Color fundus photograph · 45° FOV
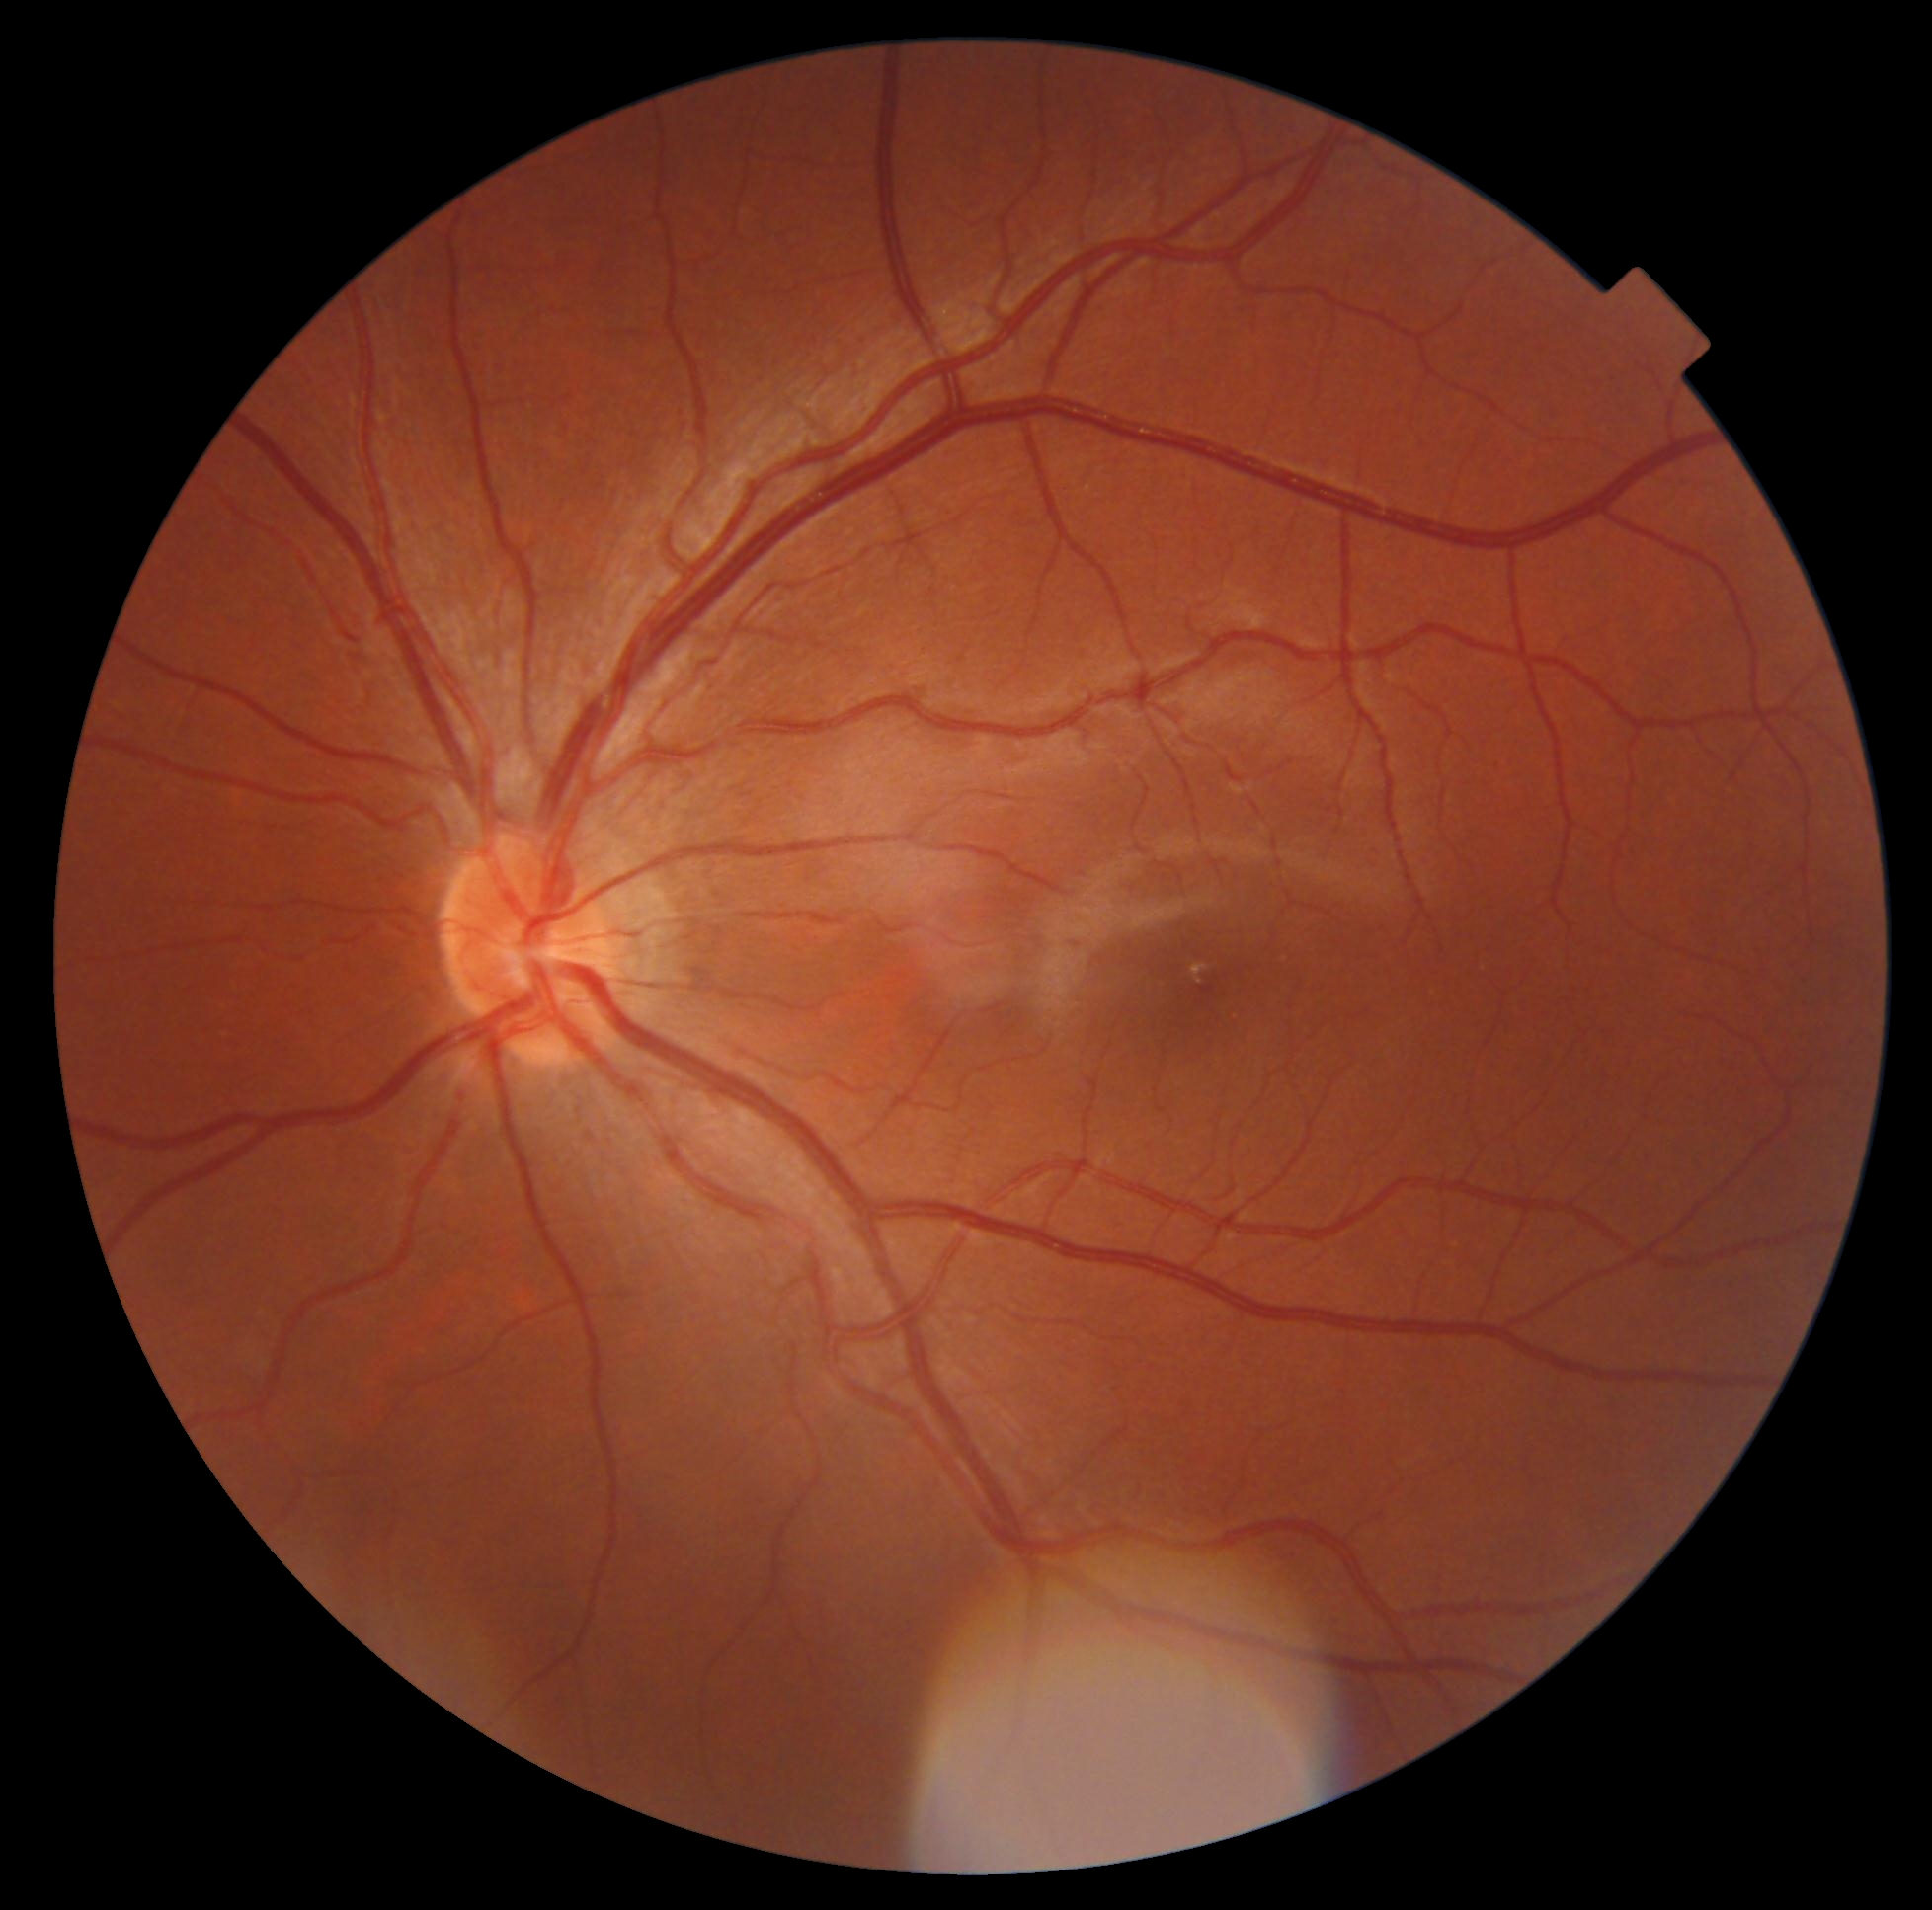
  dr_grade: 0/4